Retinal fundus photograph, 45-degree field of view, 848x848, NIDEK AFC-230, no pharmacologic dilation, modified Davis grading
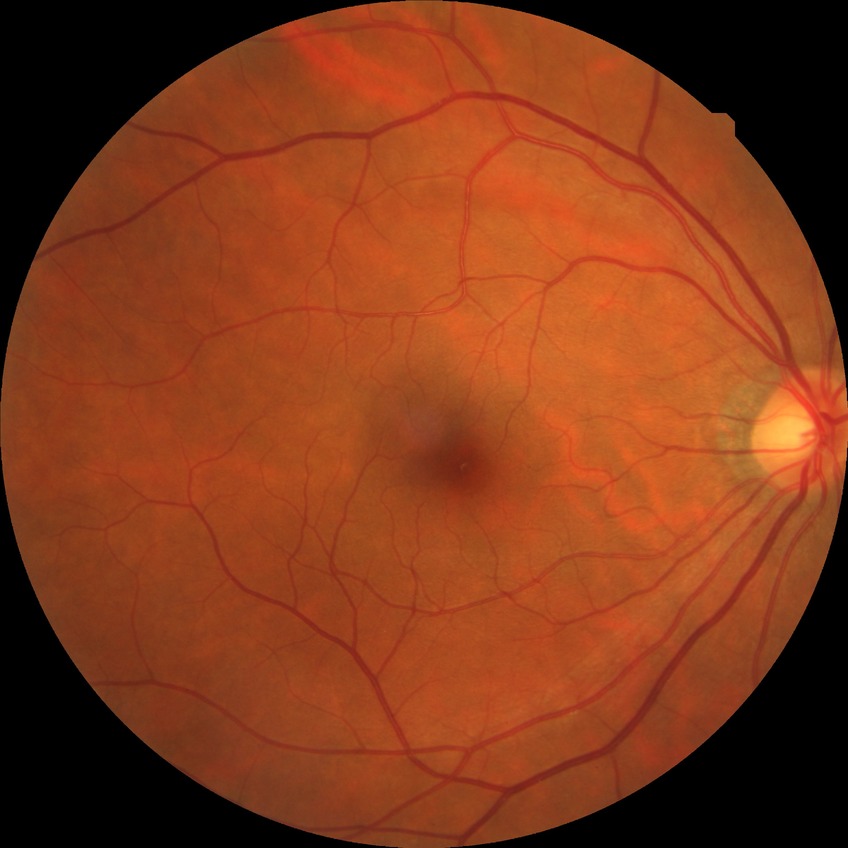
diabetic retinopathy (DR): NDR (no diabetic retinopathy)